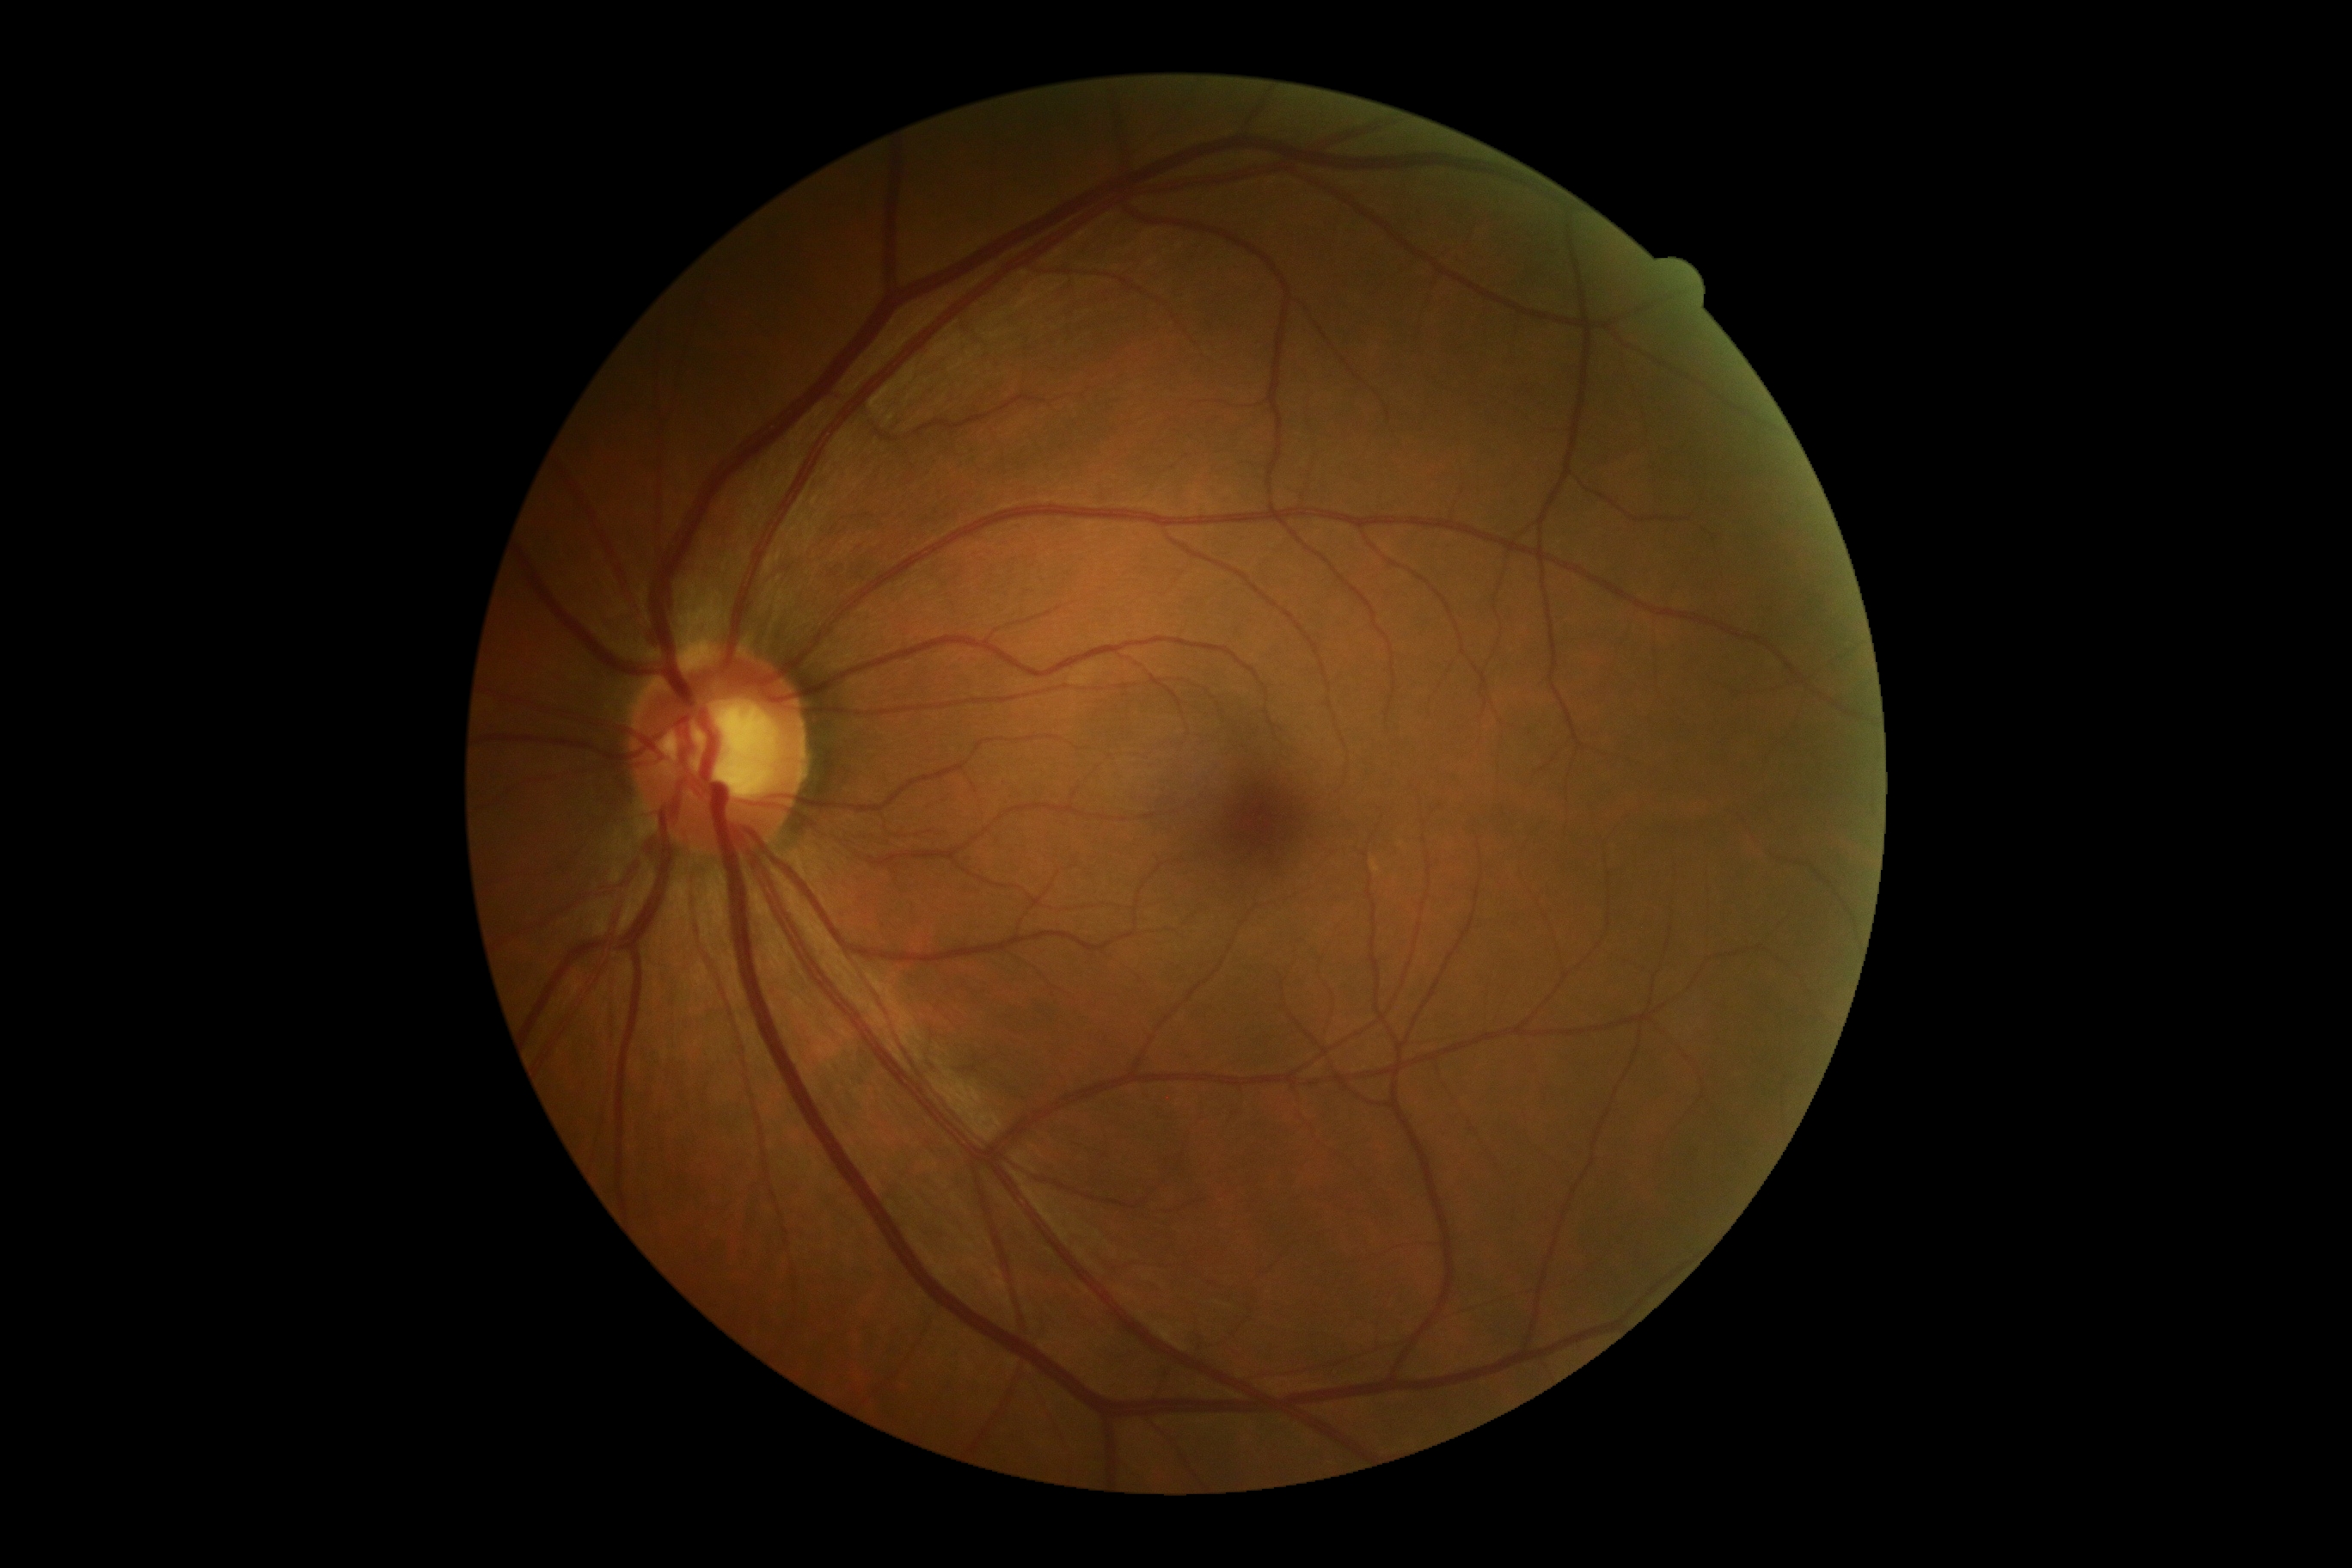
DR stage: no apparent diabetic retinopathy (grade 0).